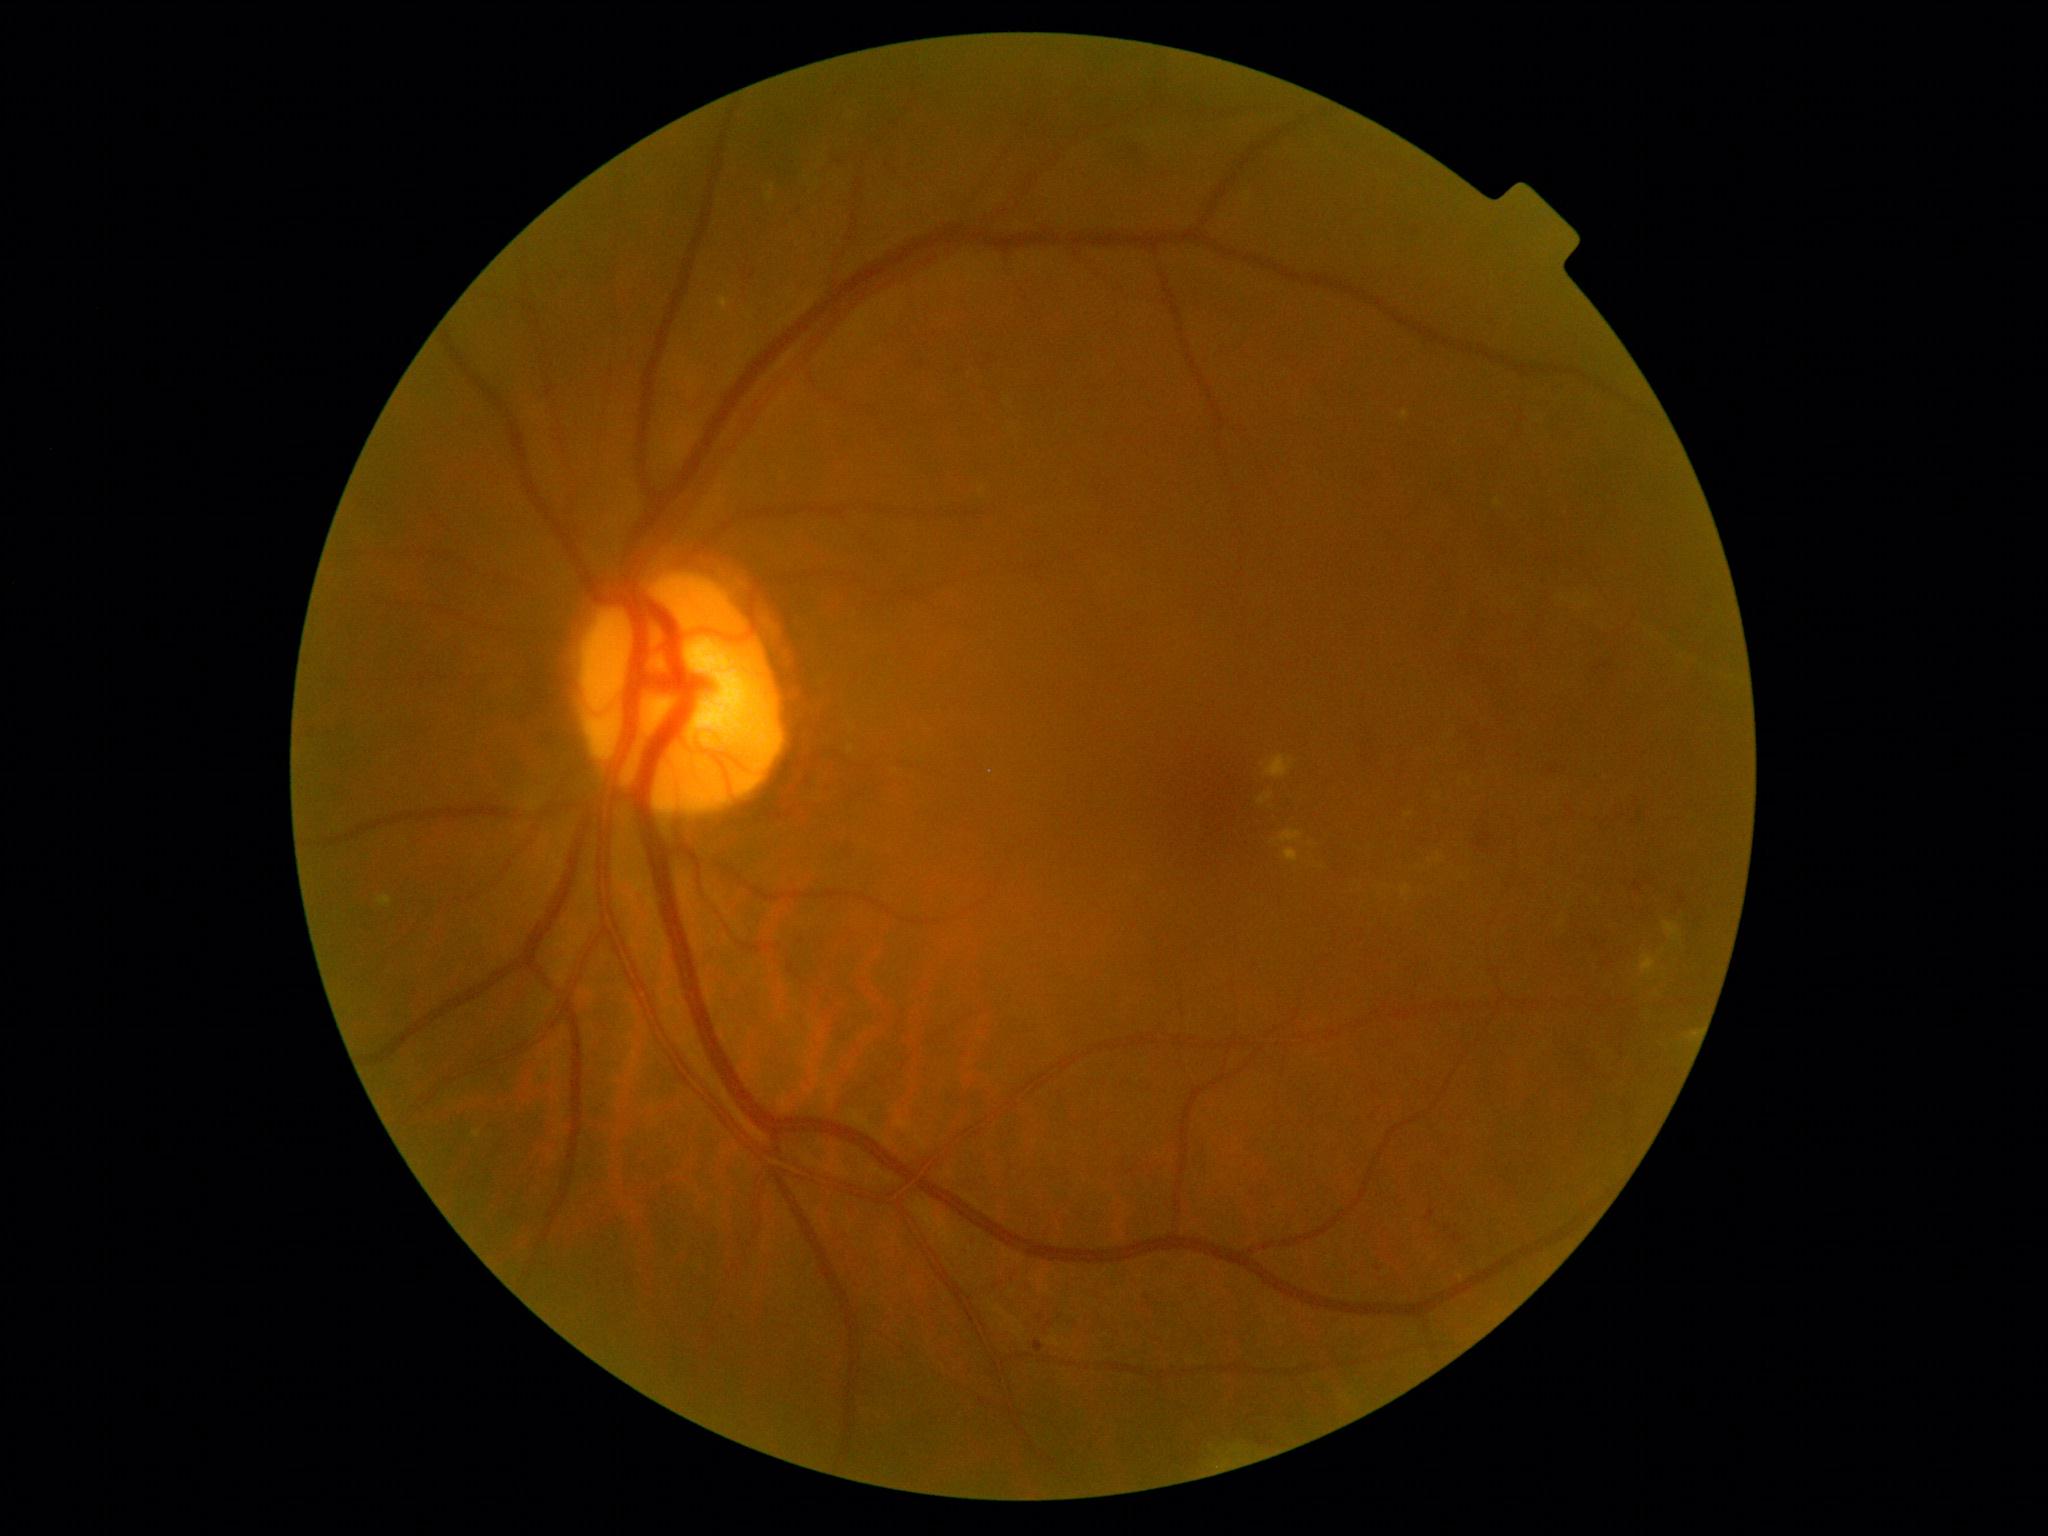
{"partial":true,"dr_grade":2,"lesions":{"se":null,"he":[[1635,882,1643,892],[1451,1233,1463,1243],[1545,768,1559,776],[747,271,757,282],[1426,1212,1436,1220],[1365,726,1380,764],[1679,894,1688,904],[1479,834,1492,848],[1126,136,1145,159]],"he_small":[[799,211],[1448,1229],[840,162]],"ma":[[1035,1341,1045,1354]],"ex":[[1689,1031,1699,1043],[1401,411,1410,420],[473,1132,482,1139],[1280,831,1302,844],[1401,885,1411,897],[767,193,772,201],[1265,756,1294,779],[378,895,393,908],[1284,849,1300,864],[719,298,731,309],[1494,499,1503,507],[1663,922,1682,943],[1258,794,1274,805],[1642,955,1656,975]],"ex_small":[[982,490],[1409,815],[1275,841]]}}